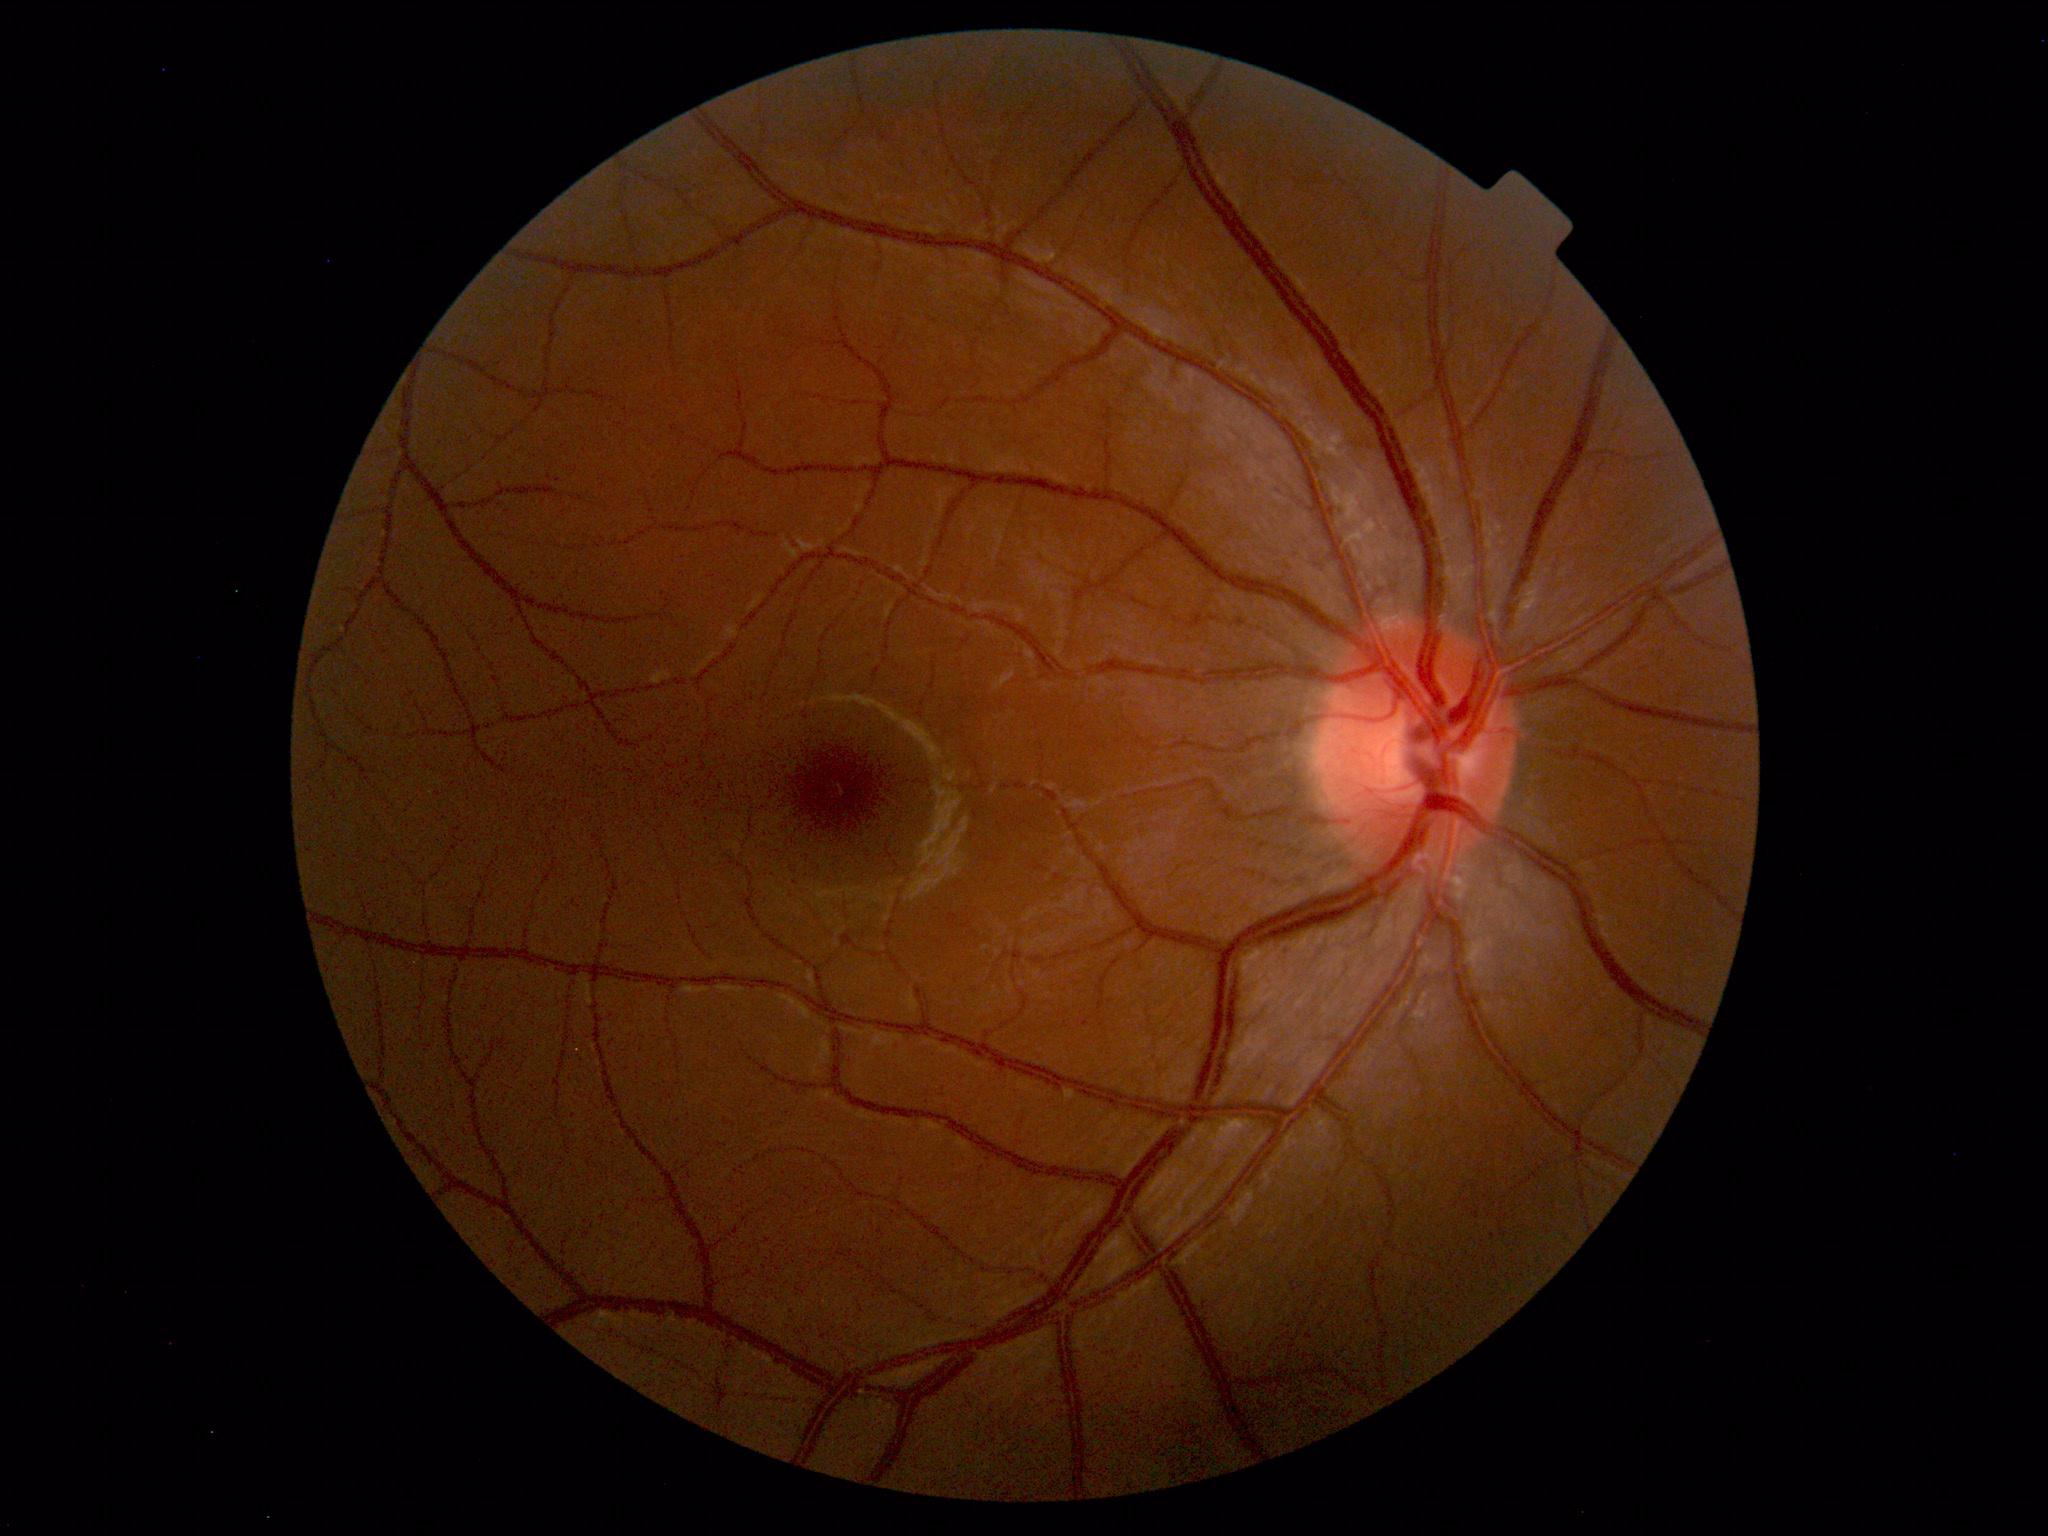

Findings: no abnormalities.